Captured on a Remidio FOP fundus camera. 1659 x 2212 pixels. Retinal fundus photograph — 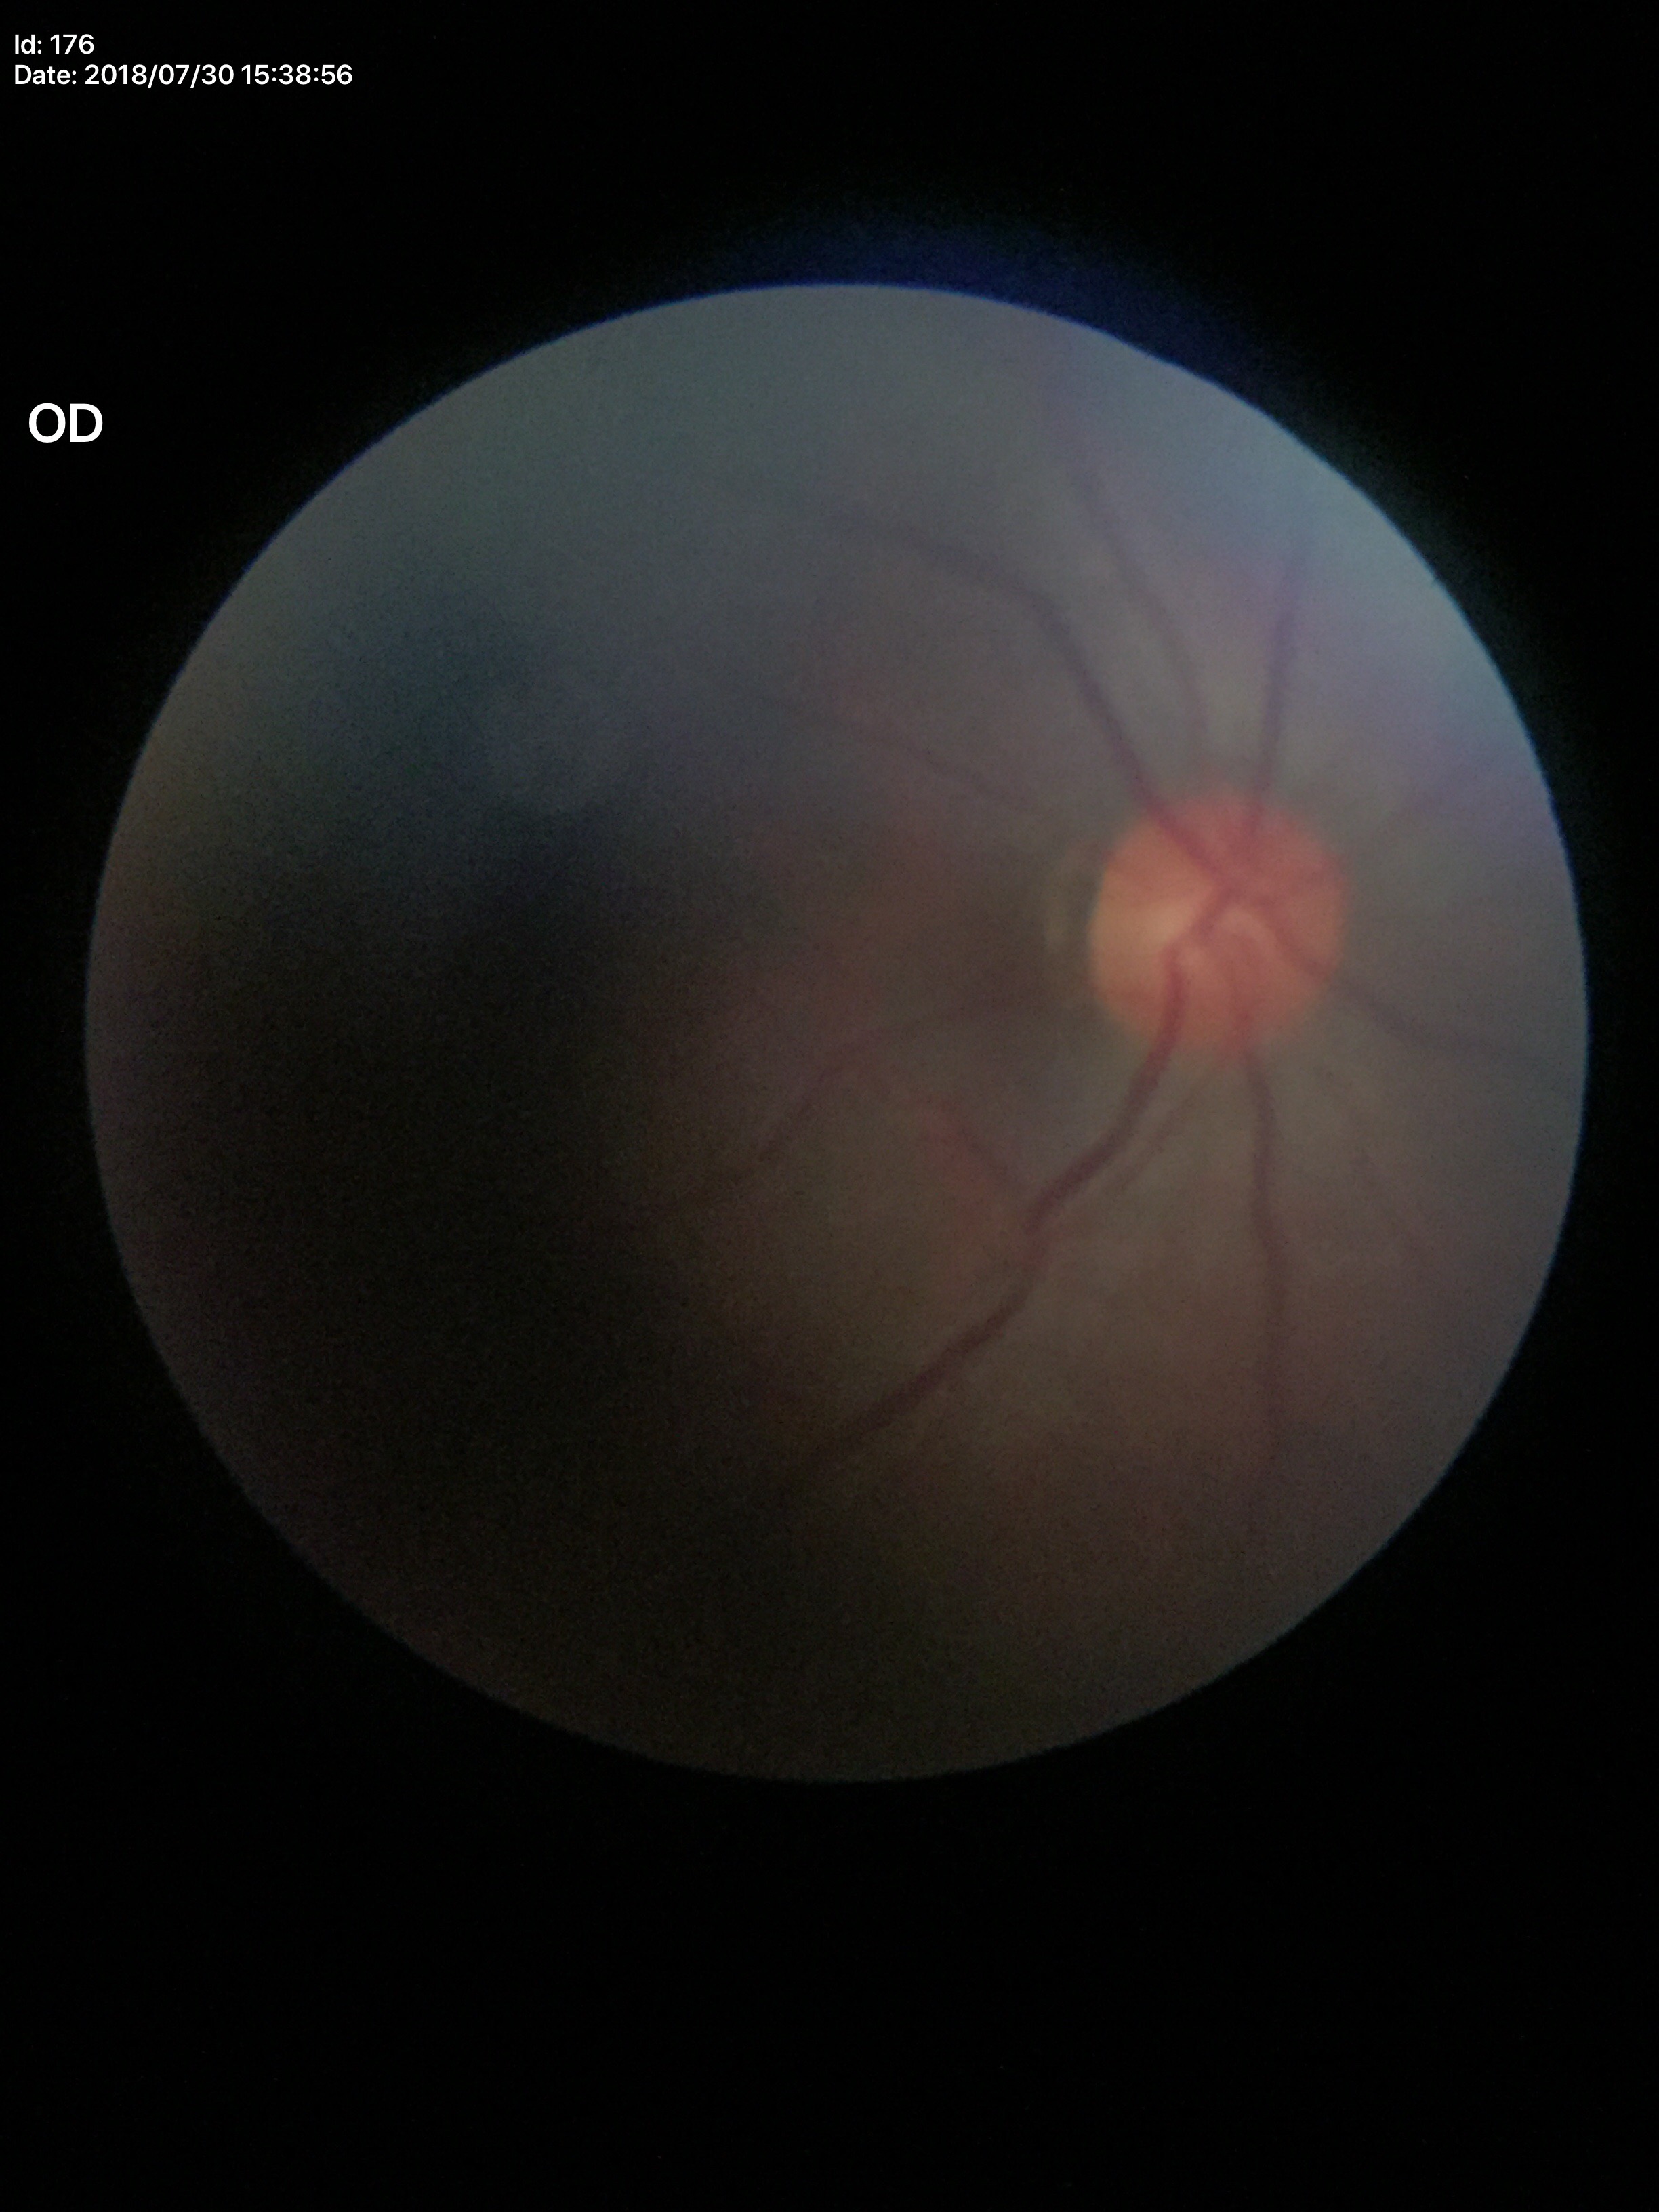 Area cup-disc ratio (ACDR) of 0.23. Vertical CDR (VCDR): 0.47. Glaucoma screening impression: negative.